45° FOV — 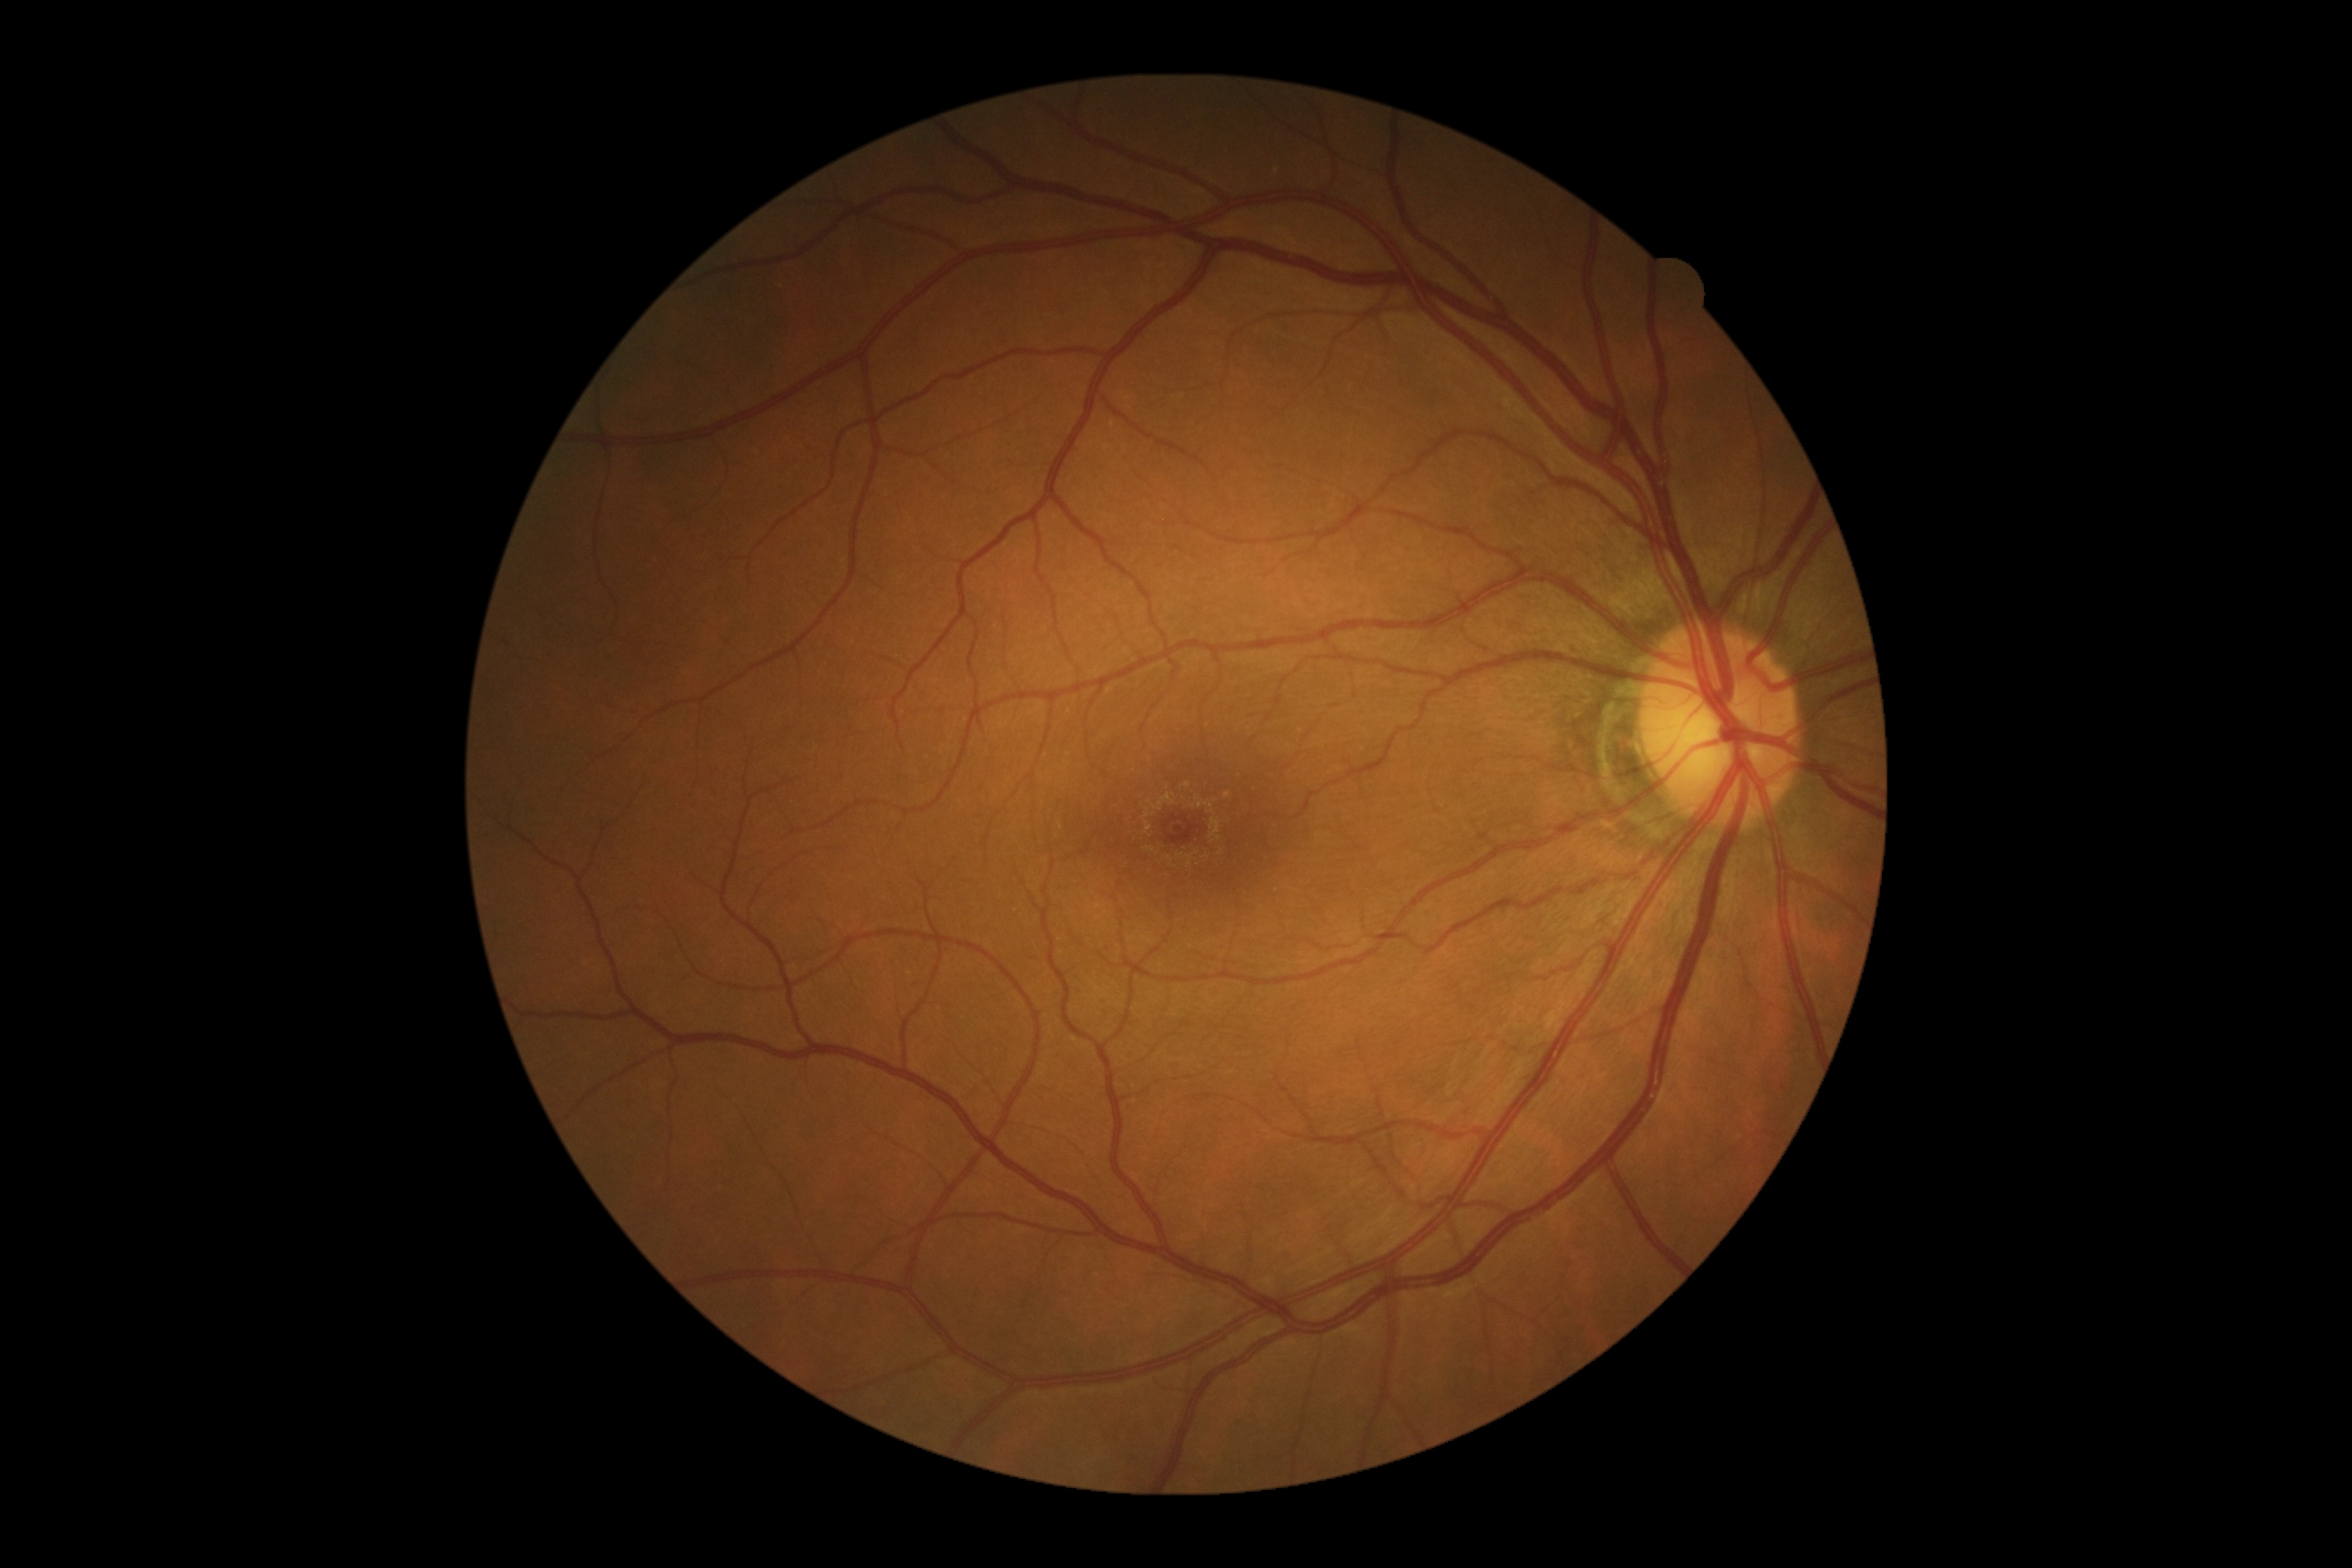

dr_grade: grade 0 (no apparent retinopathy)